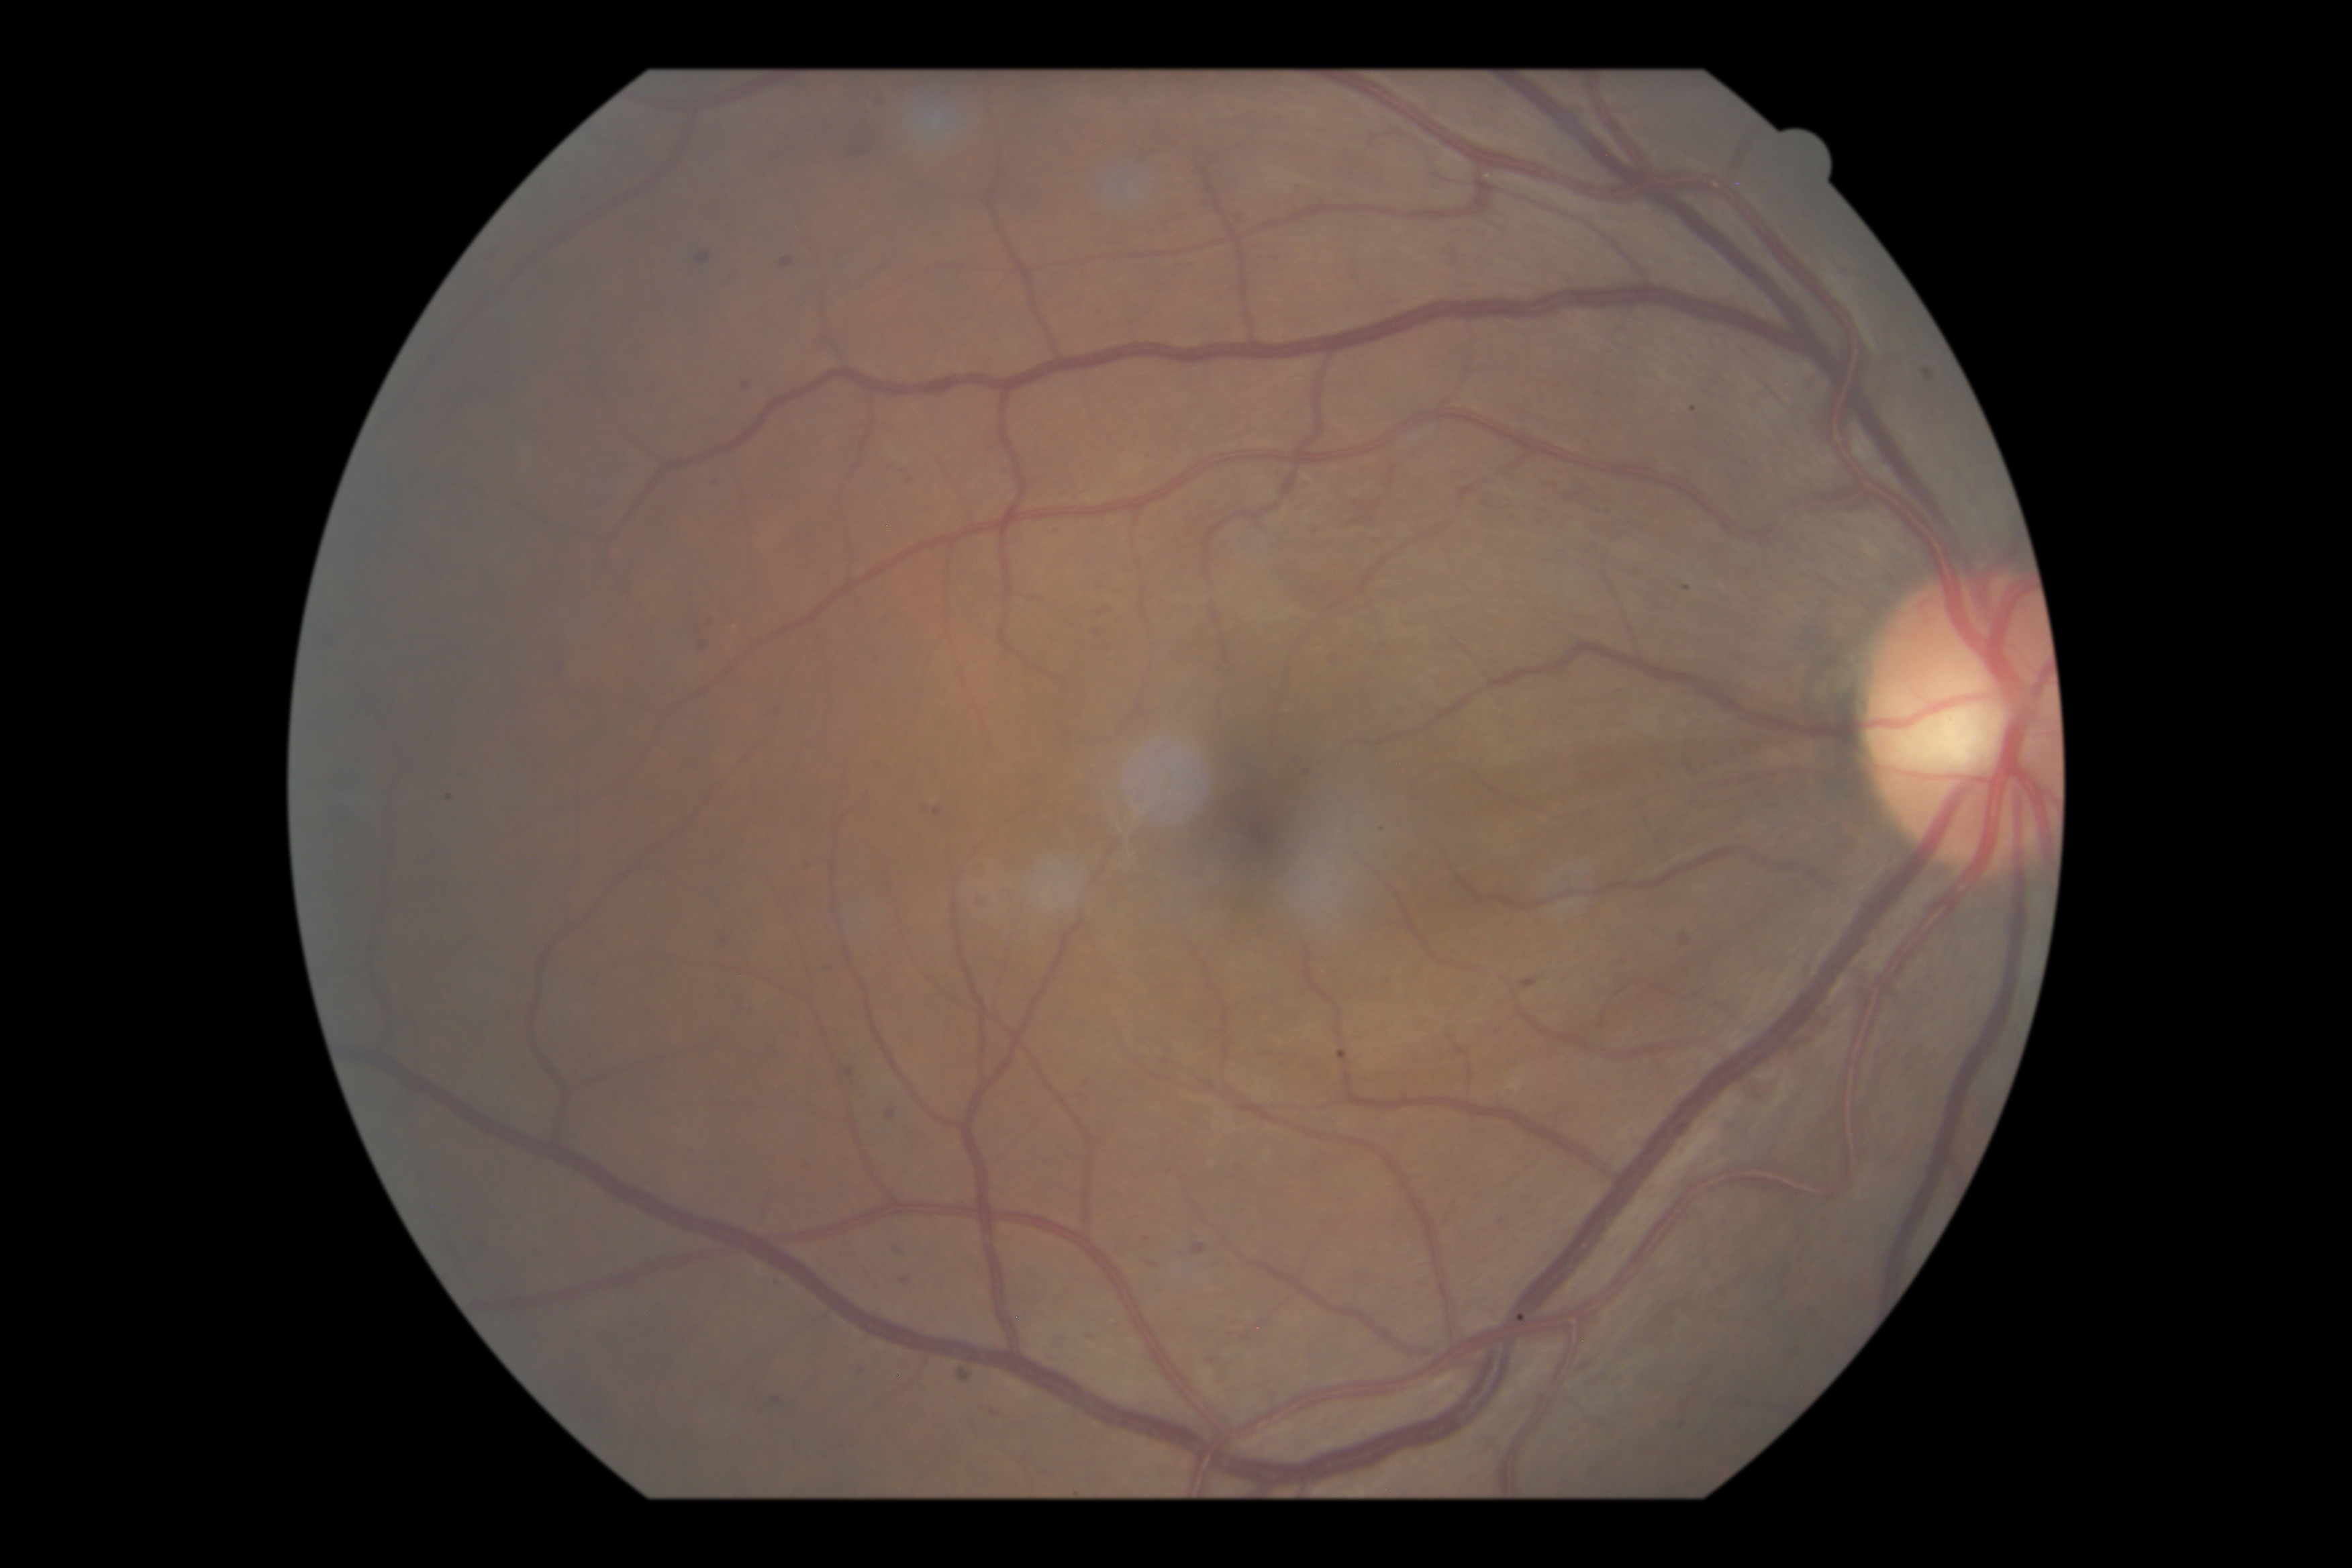 DR = moderate non-proliferative diabetic retinopathy (grade 2)